Retinal fundus photograph.
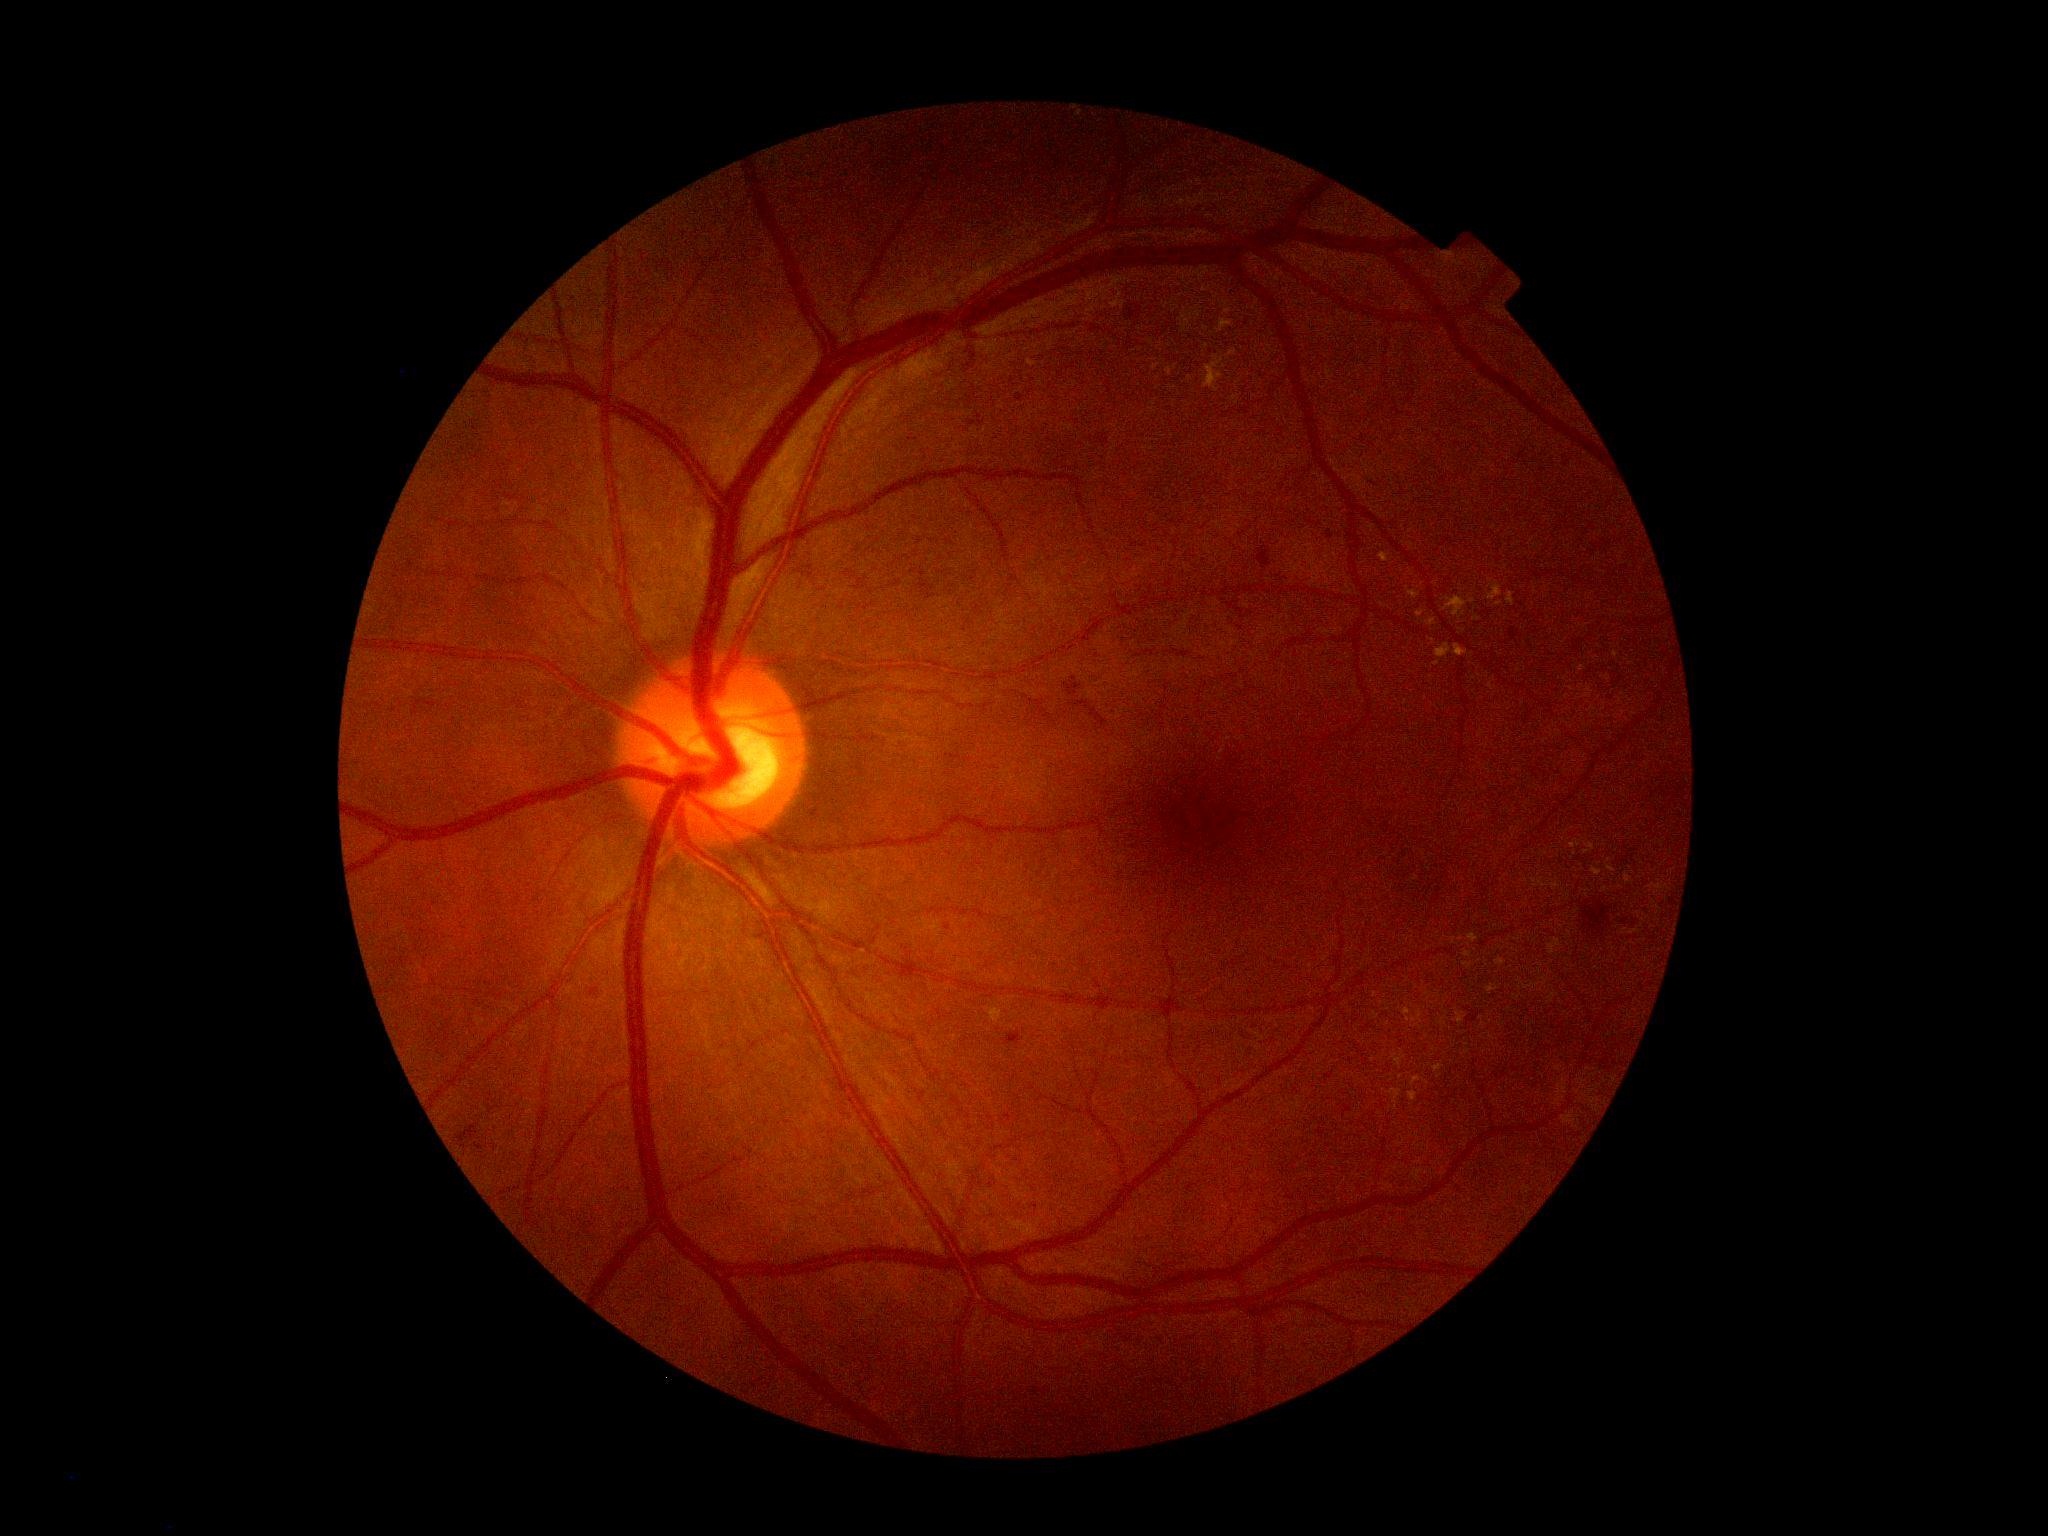

DR severity is grade 2.